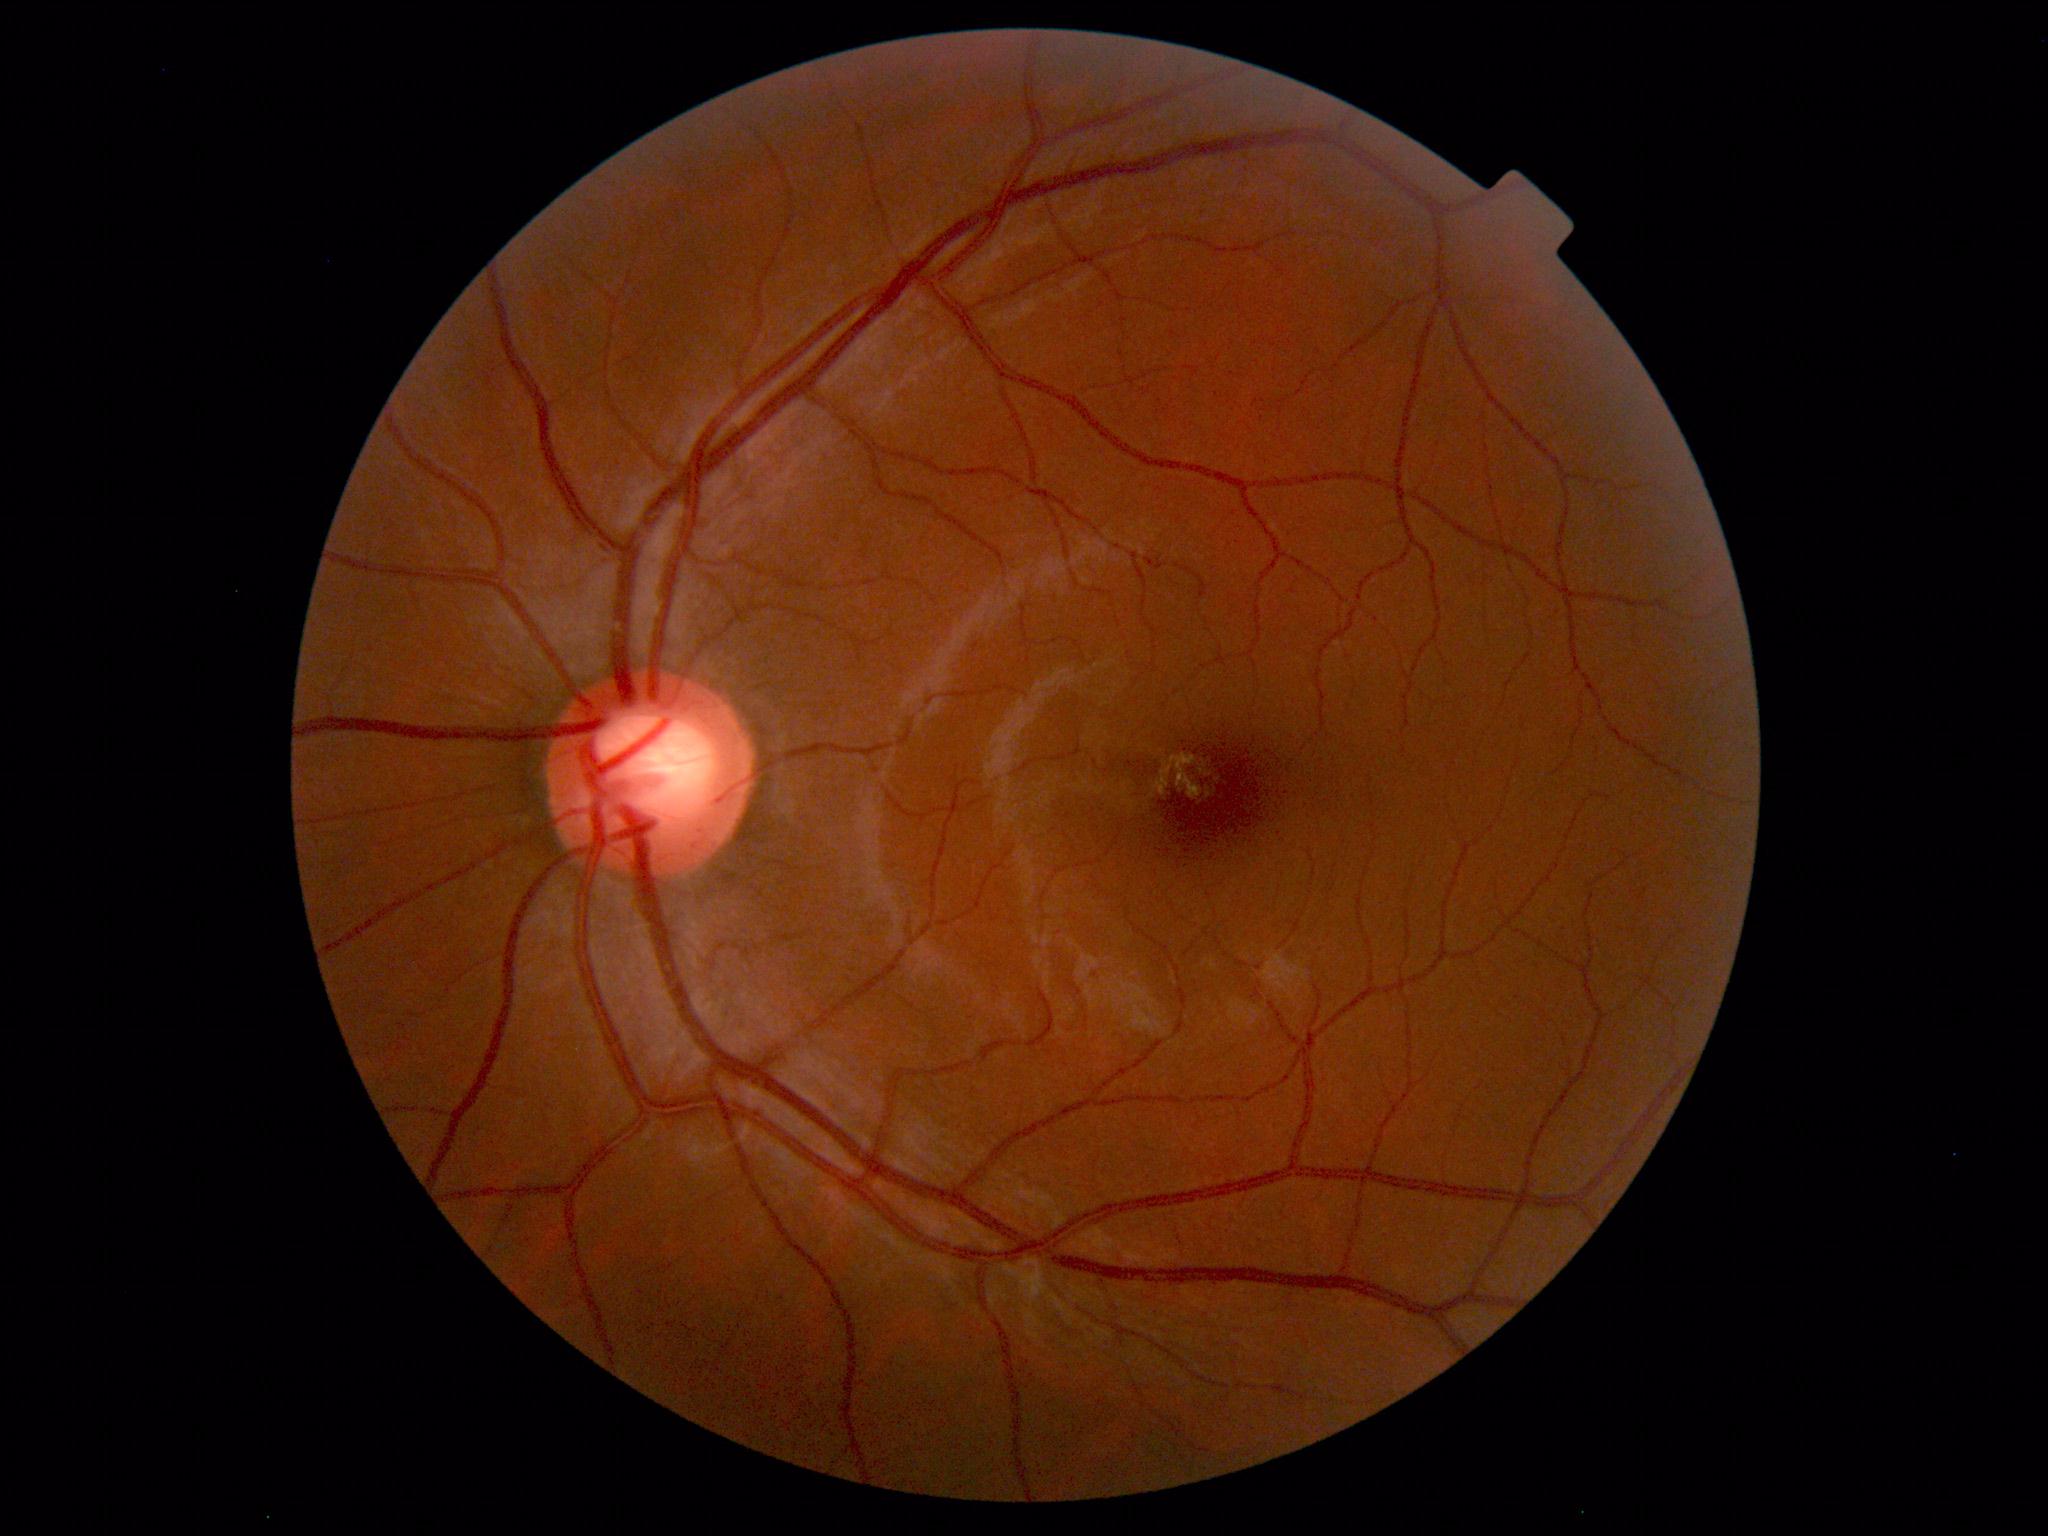 Diagnosis: normal.